Color fundus image — 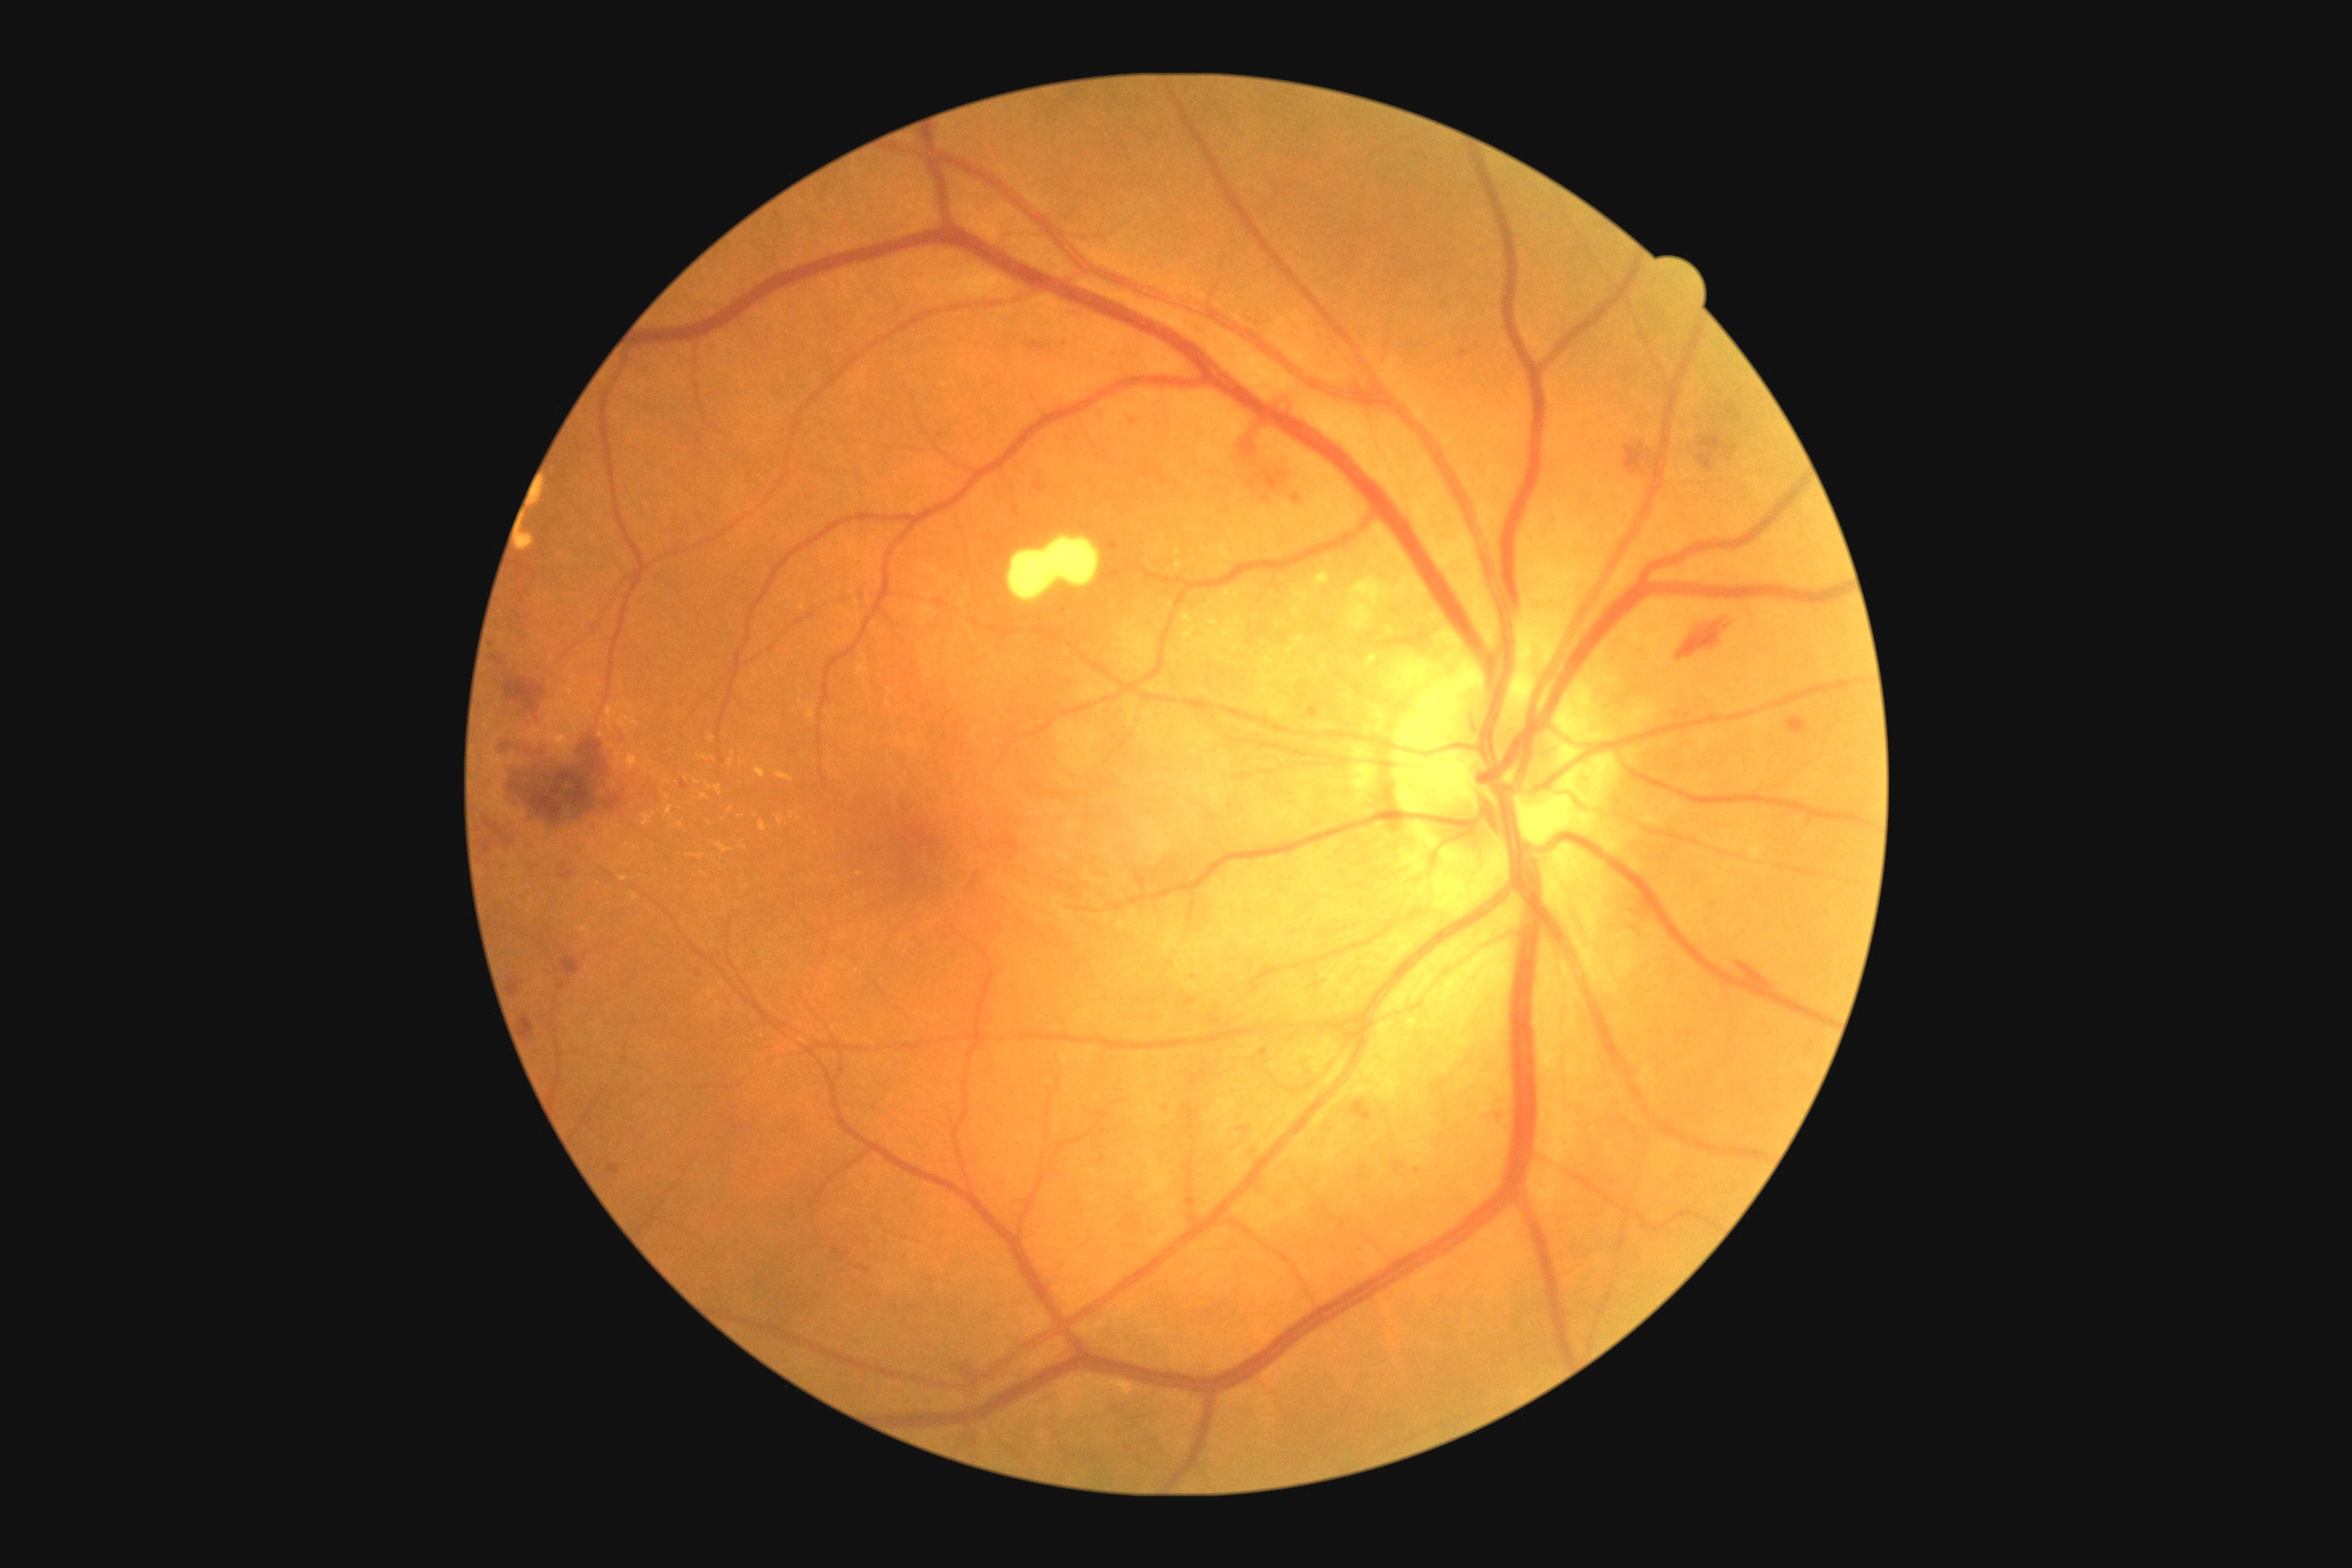 Diabetic retinopathy (DR): grade 2 (moderate NPDR) — more than just microaneurysms but less than severe NPDR. Hemorrhages (HEs) are present, including at x1=1230 y1=393 x2=1311 y2=507; x1=1672 y1=612 x2=1738 y2=663; x1=1142 y1=473 x2=1150 y2=478; x1=609 y1=1166 x2=620 y2=1175; x1=1302 y1=700 x2=1320 y2=721; x1=1259 y1=1050 x2=1268 y2=1057; x1=1723 y1=407 x2=1745 y2=422; x1=509 y1=979 x2=524 y2=997; x1=681 y1=781 x2=689 y2=789; x1=1395 y1=1161 x2=1406 y2=1175; x1=560 y1=872 x2=574 y2=879; x1=1734 y1=963 x2=1776 y2=992; x1=1482 y1=1097 x2=1507 y2=1128. HEs (small, approximate centers) near (565,868); (1134,423). Hard exudates (EXs) are present, including at x1=778 y1=816 x2=783 y2=825; x1=1206 y1=618 x2=1217 y2=627; x1=700 y1=794 x2=709 y2=801; x1=1349 y1=580 x2=1384 y2=627; x1=705 y1=783 x2=721 y2=796; x1=618 y1=716 x2=640 y2=729; x1=607 y1=707 x2=614 y2=730; x1=689 y1=854 x2=703 y2=859; x1=625 y1=843 x2=640 y2=852. EXs (small, approximate centers) near (712,739); (799,819); (584,929); (1178,553); (687,779).